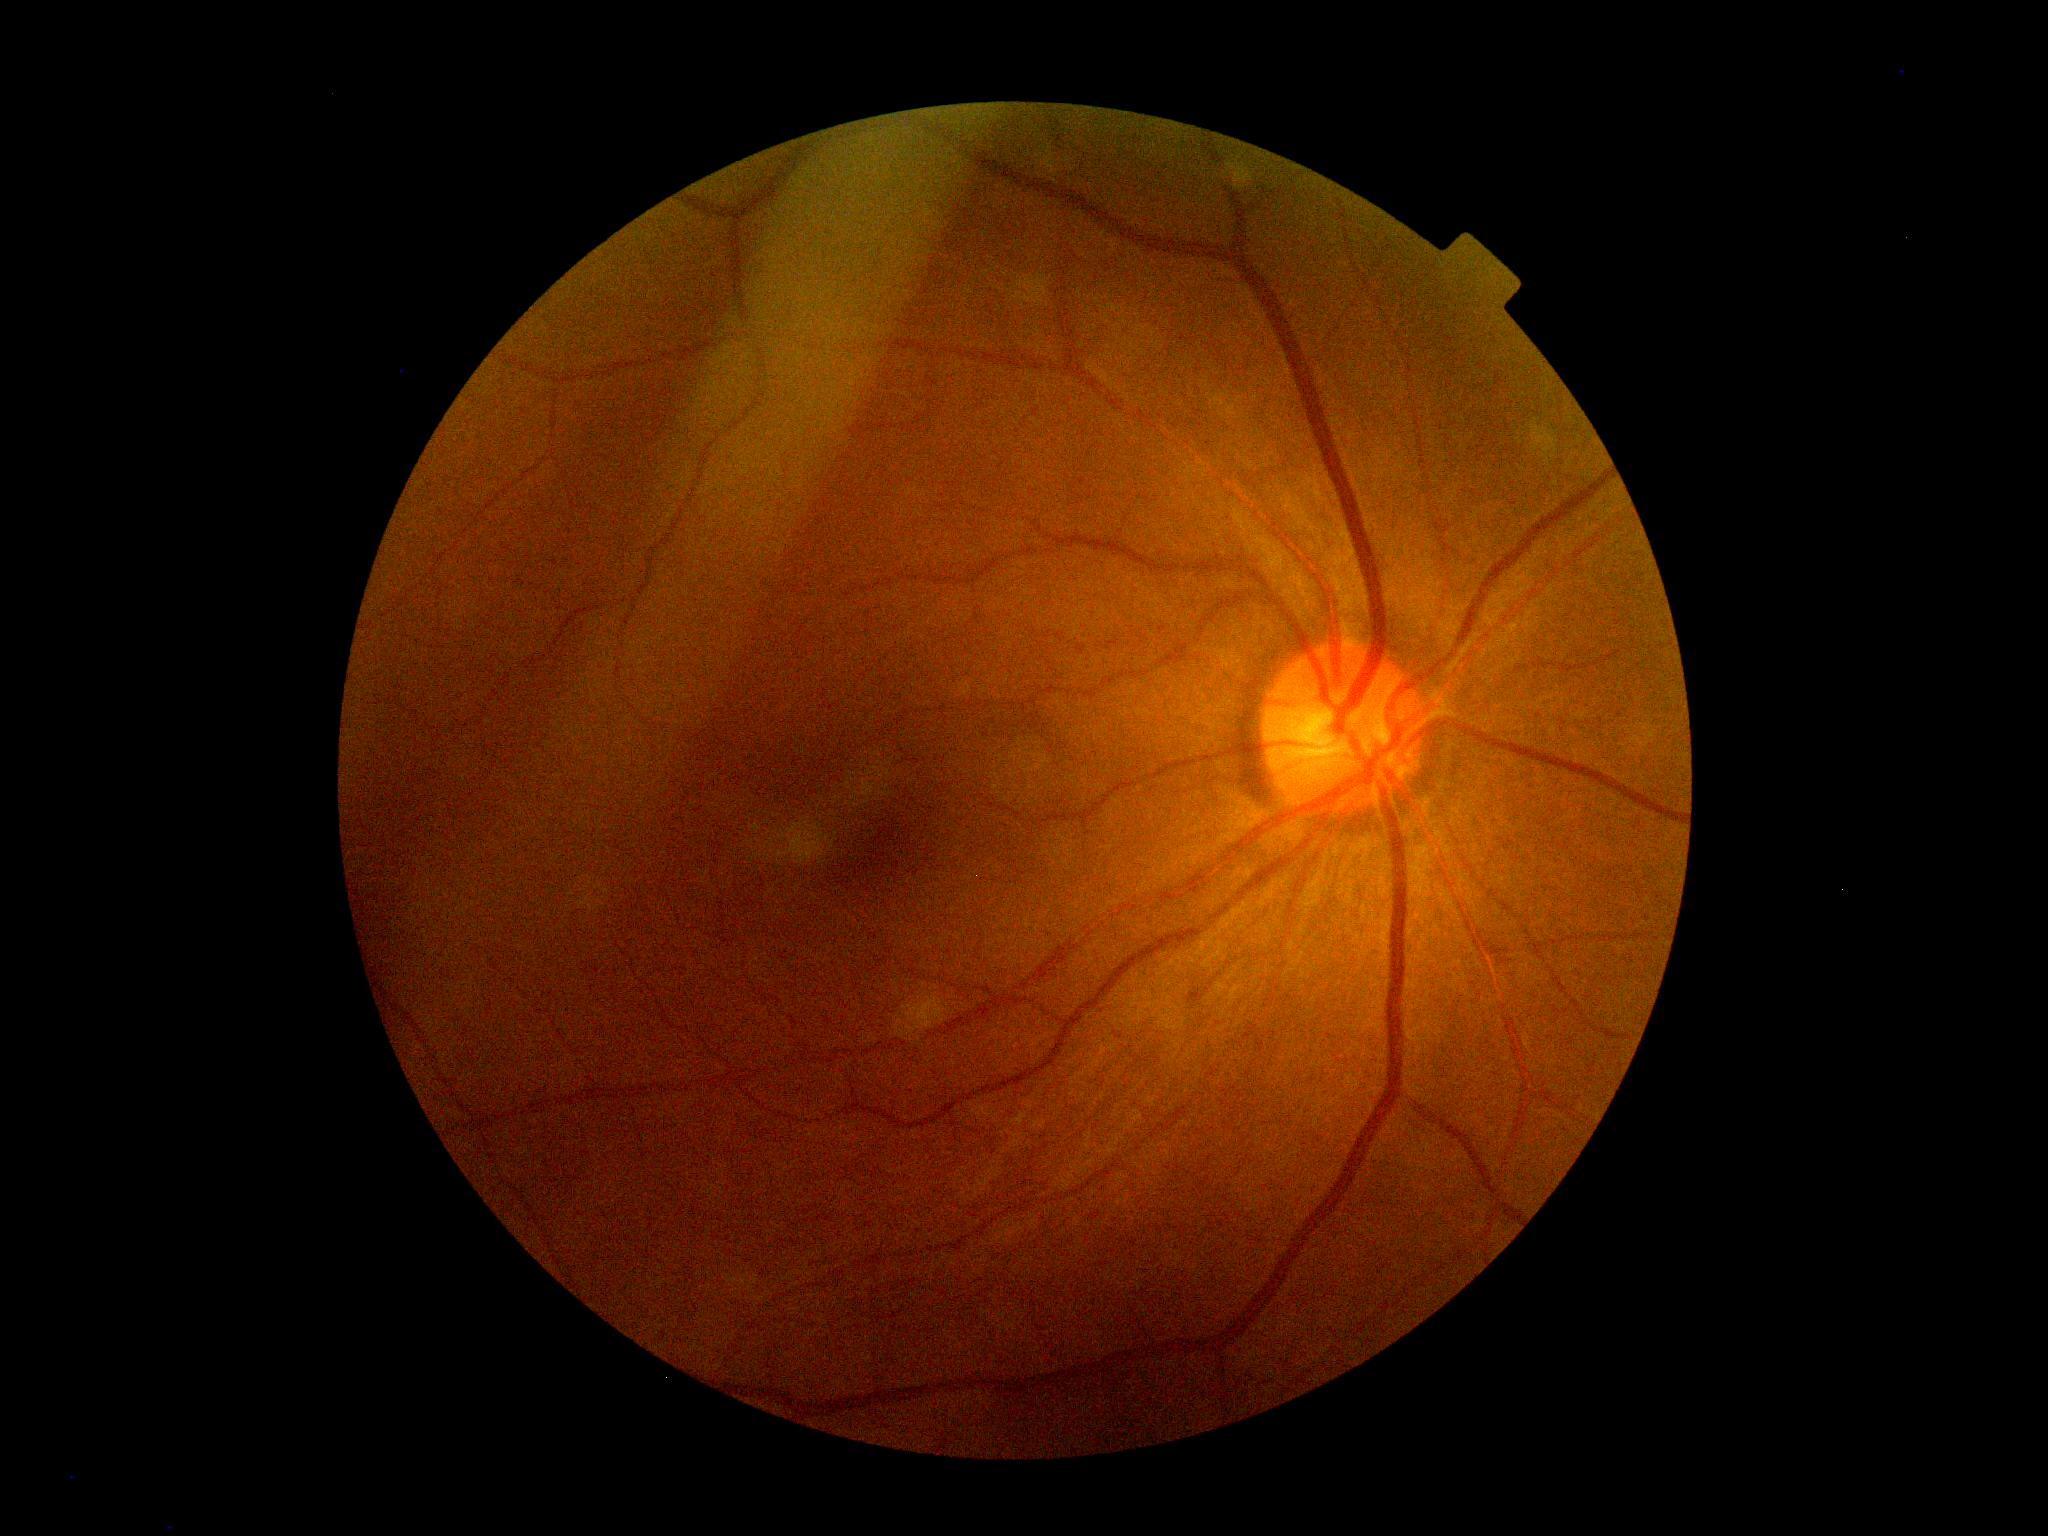   dr_grade: 0 (no apparent retinopathy)
  dr_impression: negative for DR